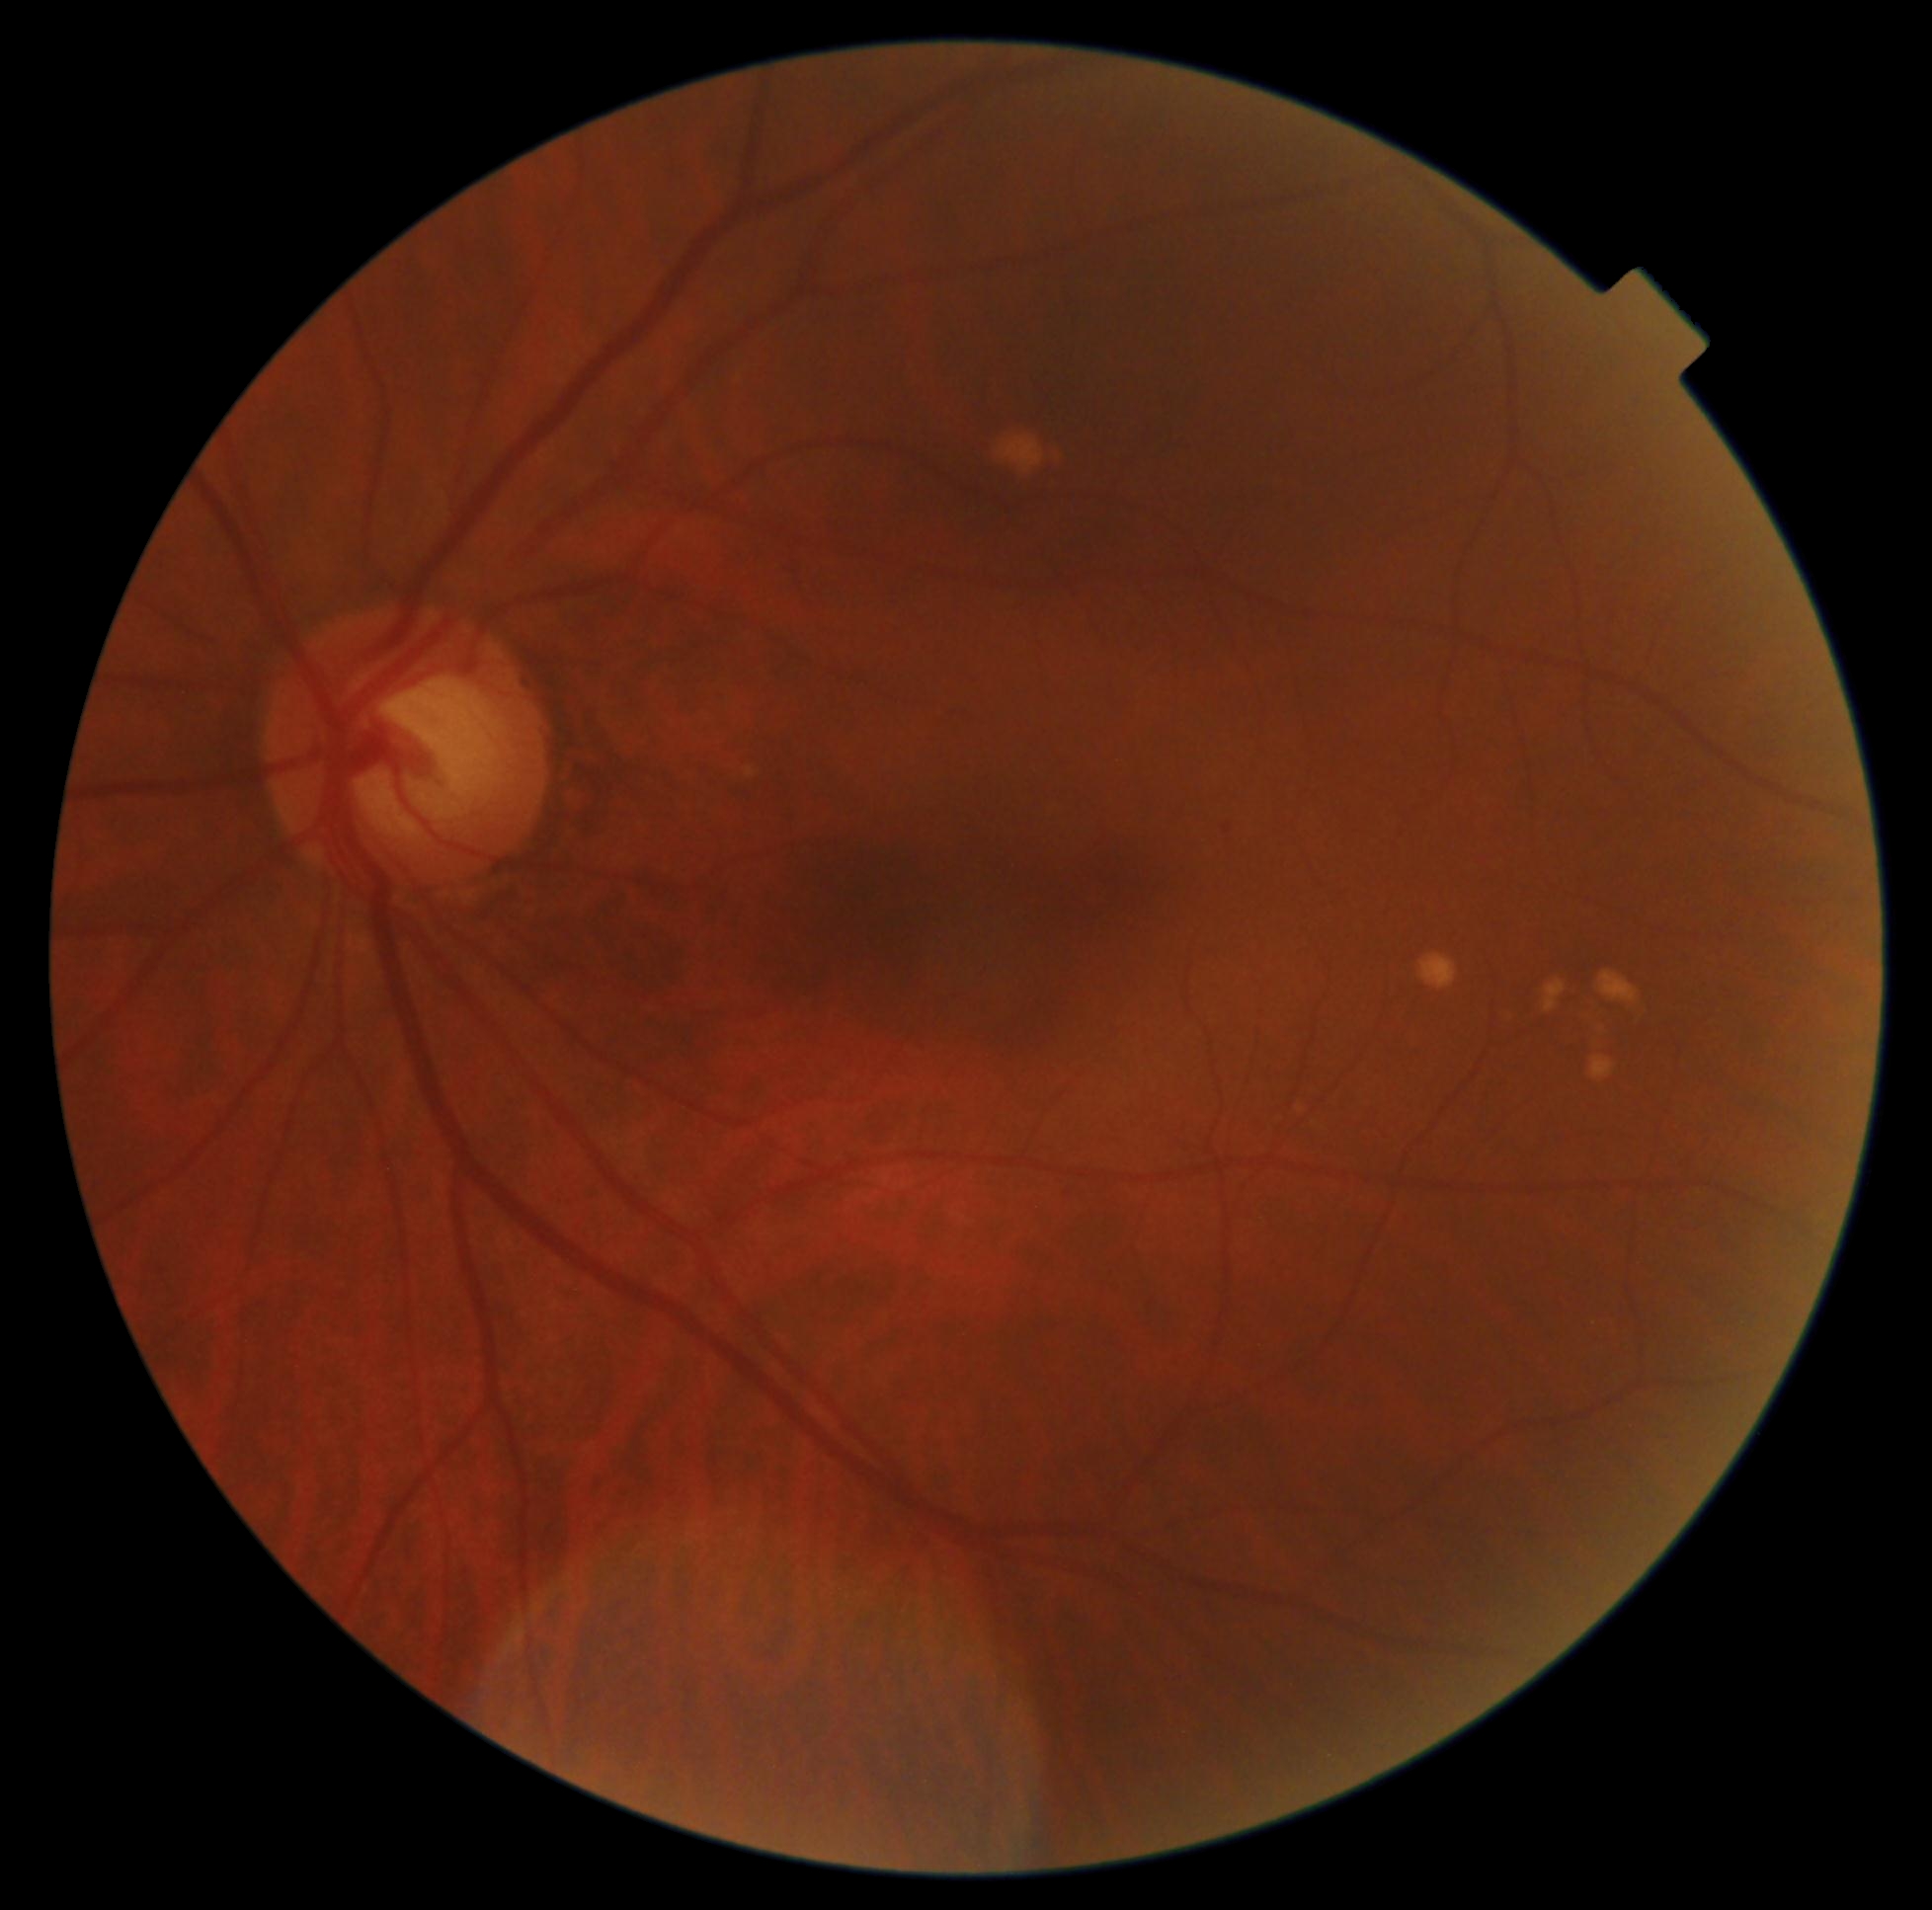

Diabetic retinopathy (DR) is grade 1 — presence of microaneurysms only.
The retinopathy is classified as non-proliferative diabetic retinopathy.